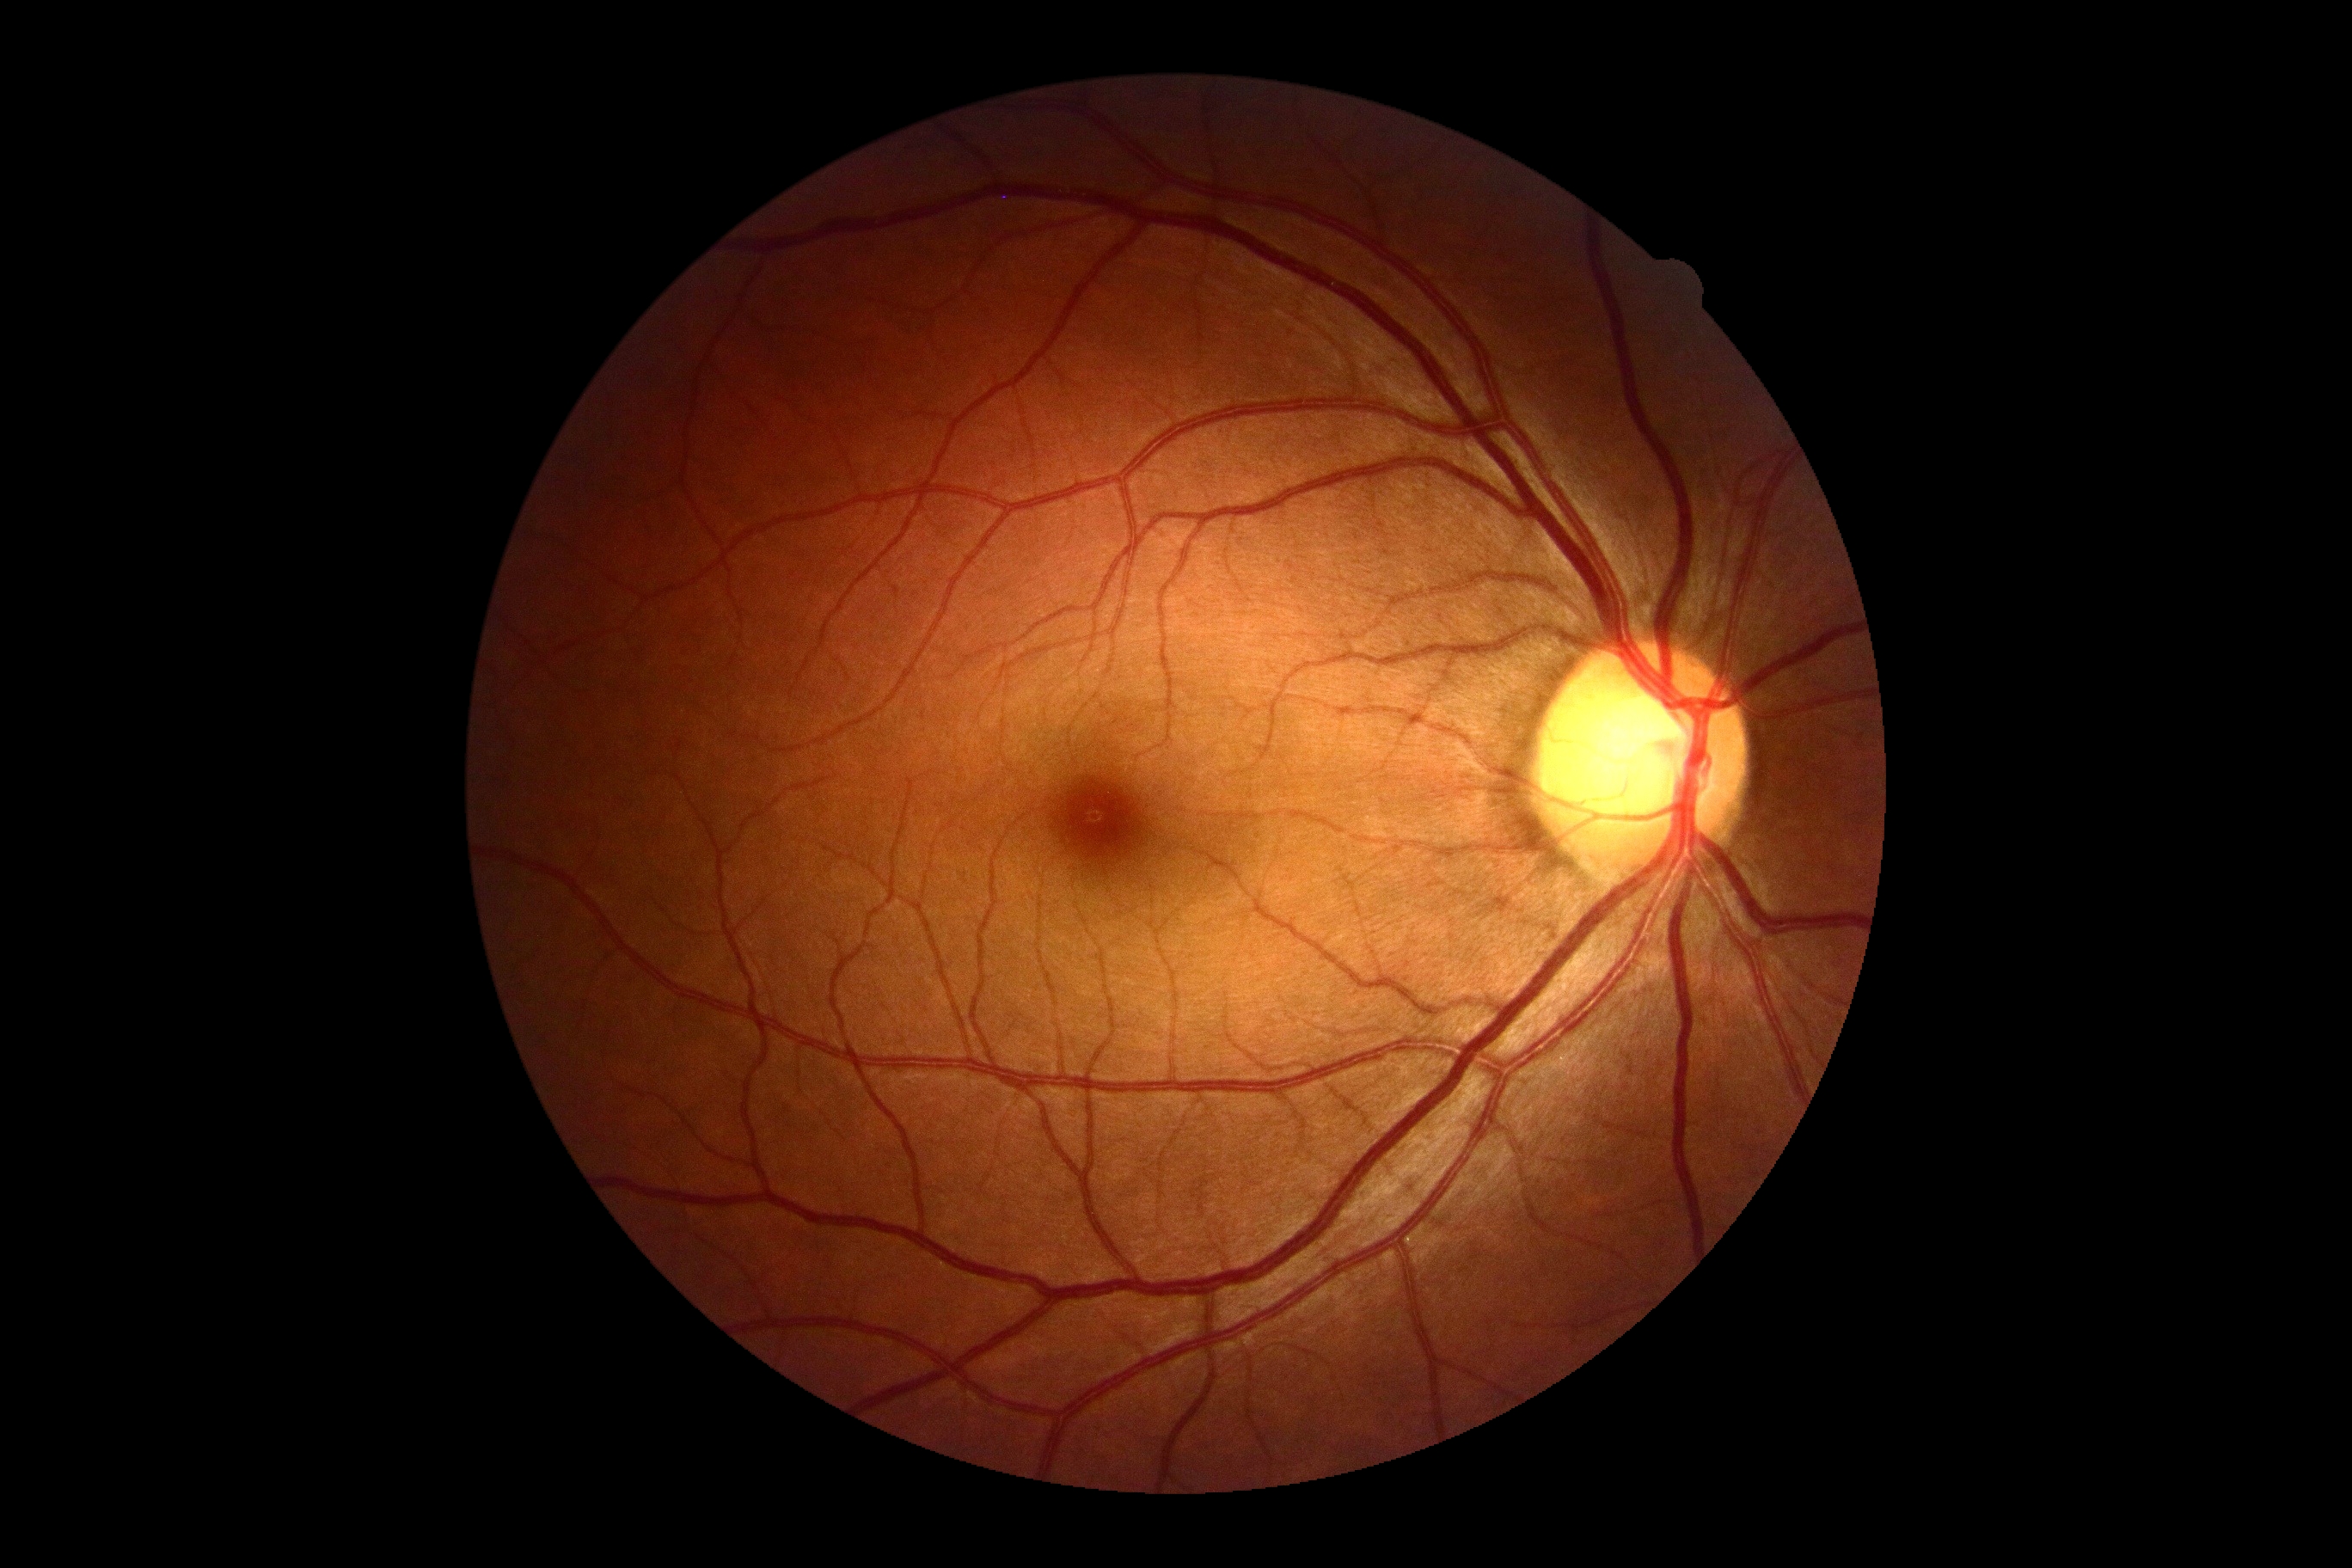

Diabetic retinopathy (DR) is no apparent diabetic retinopathy (grade 0) — no visible signs of diabetic retinopathy.